2184 by 1690 pixels; 45° FOV:
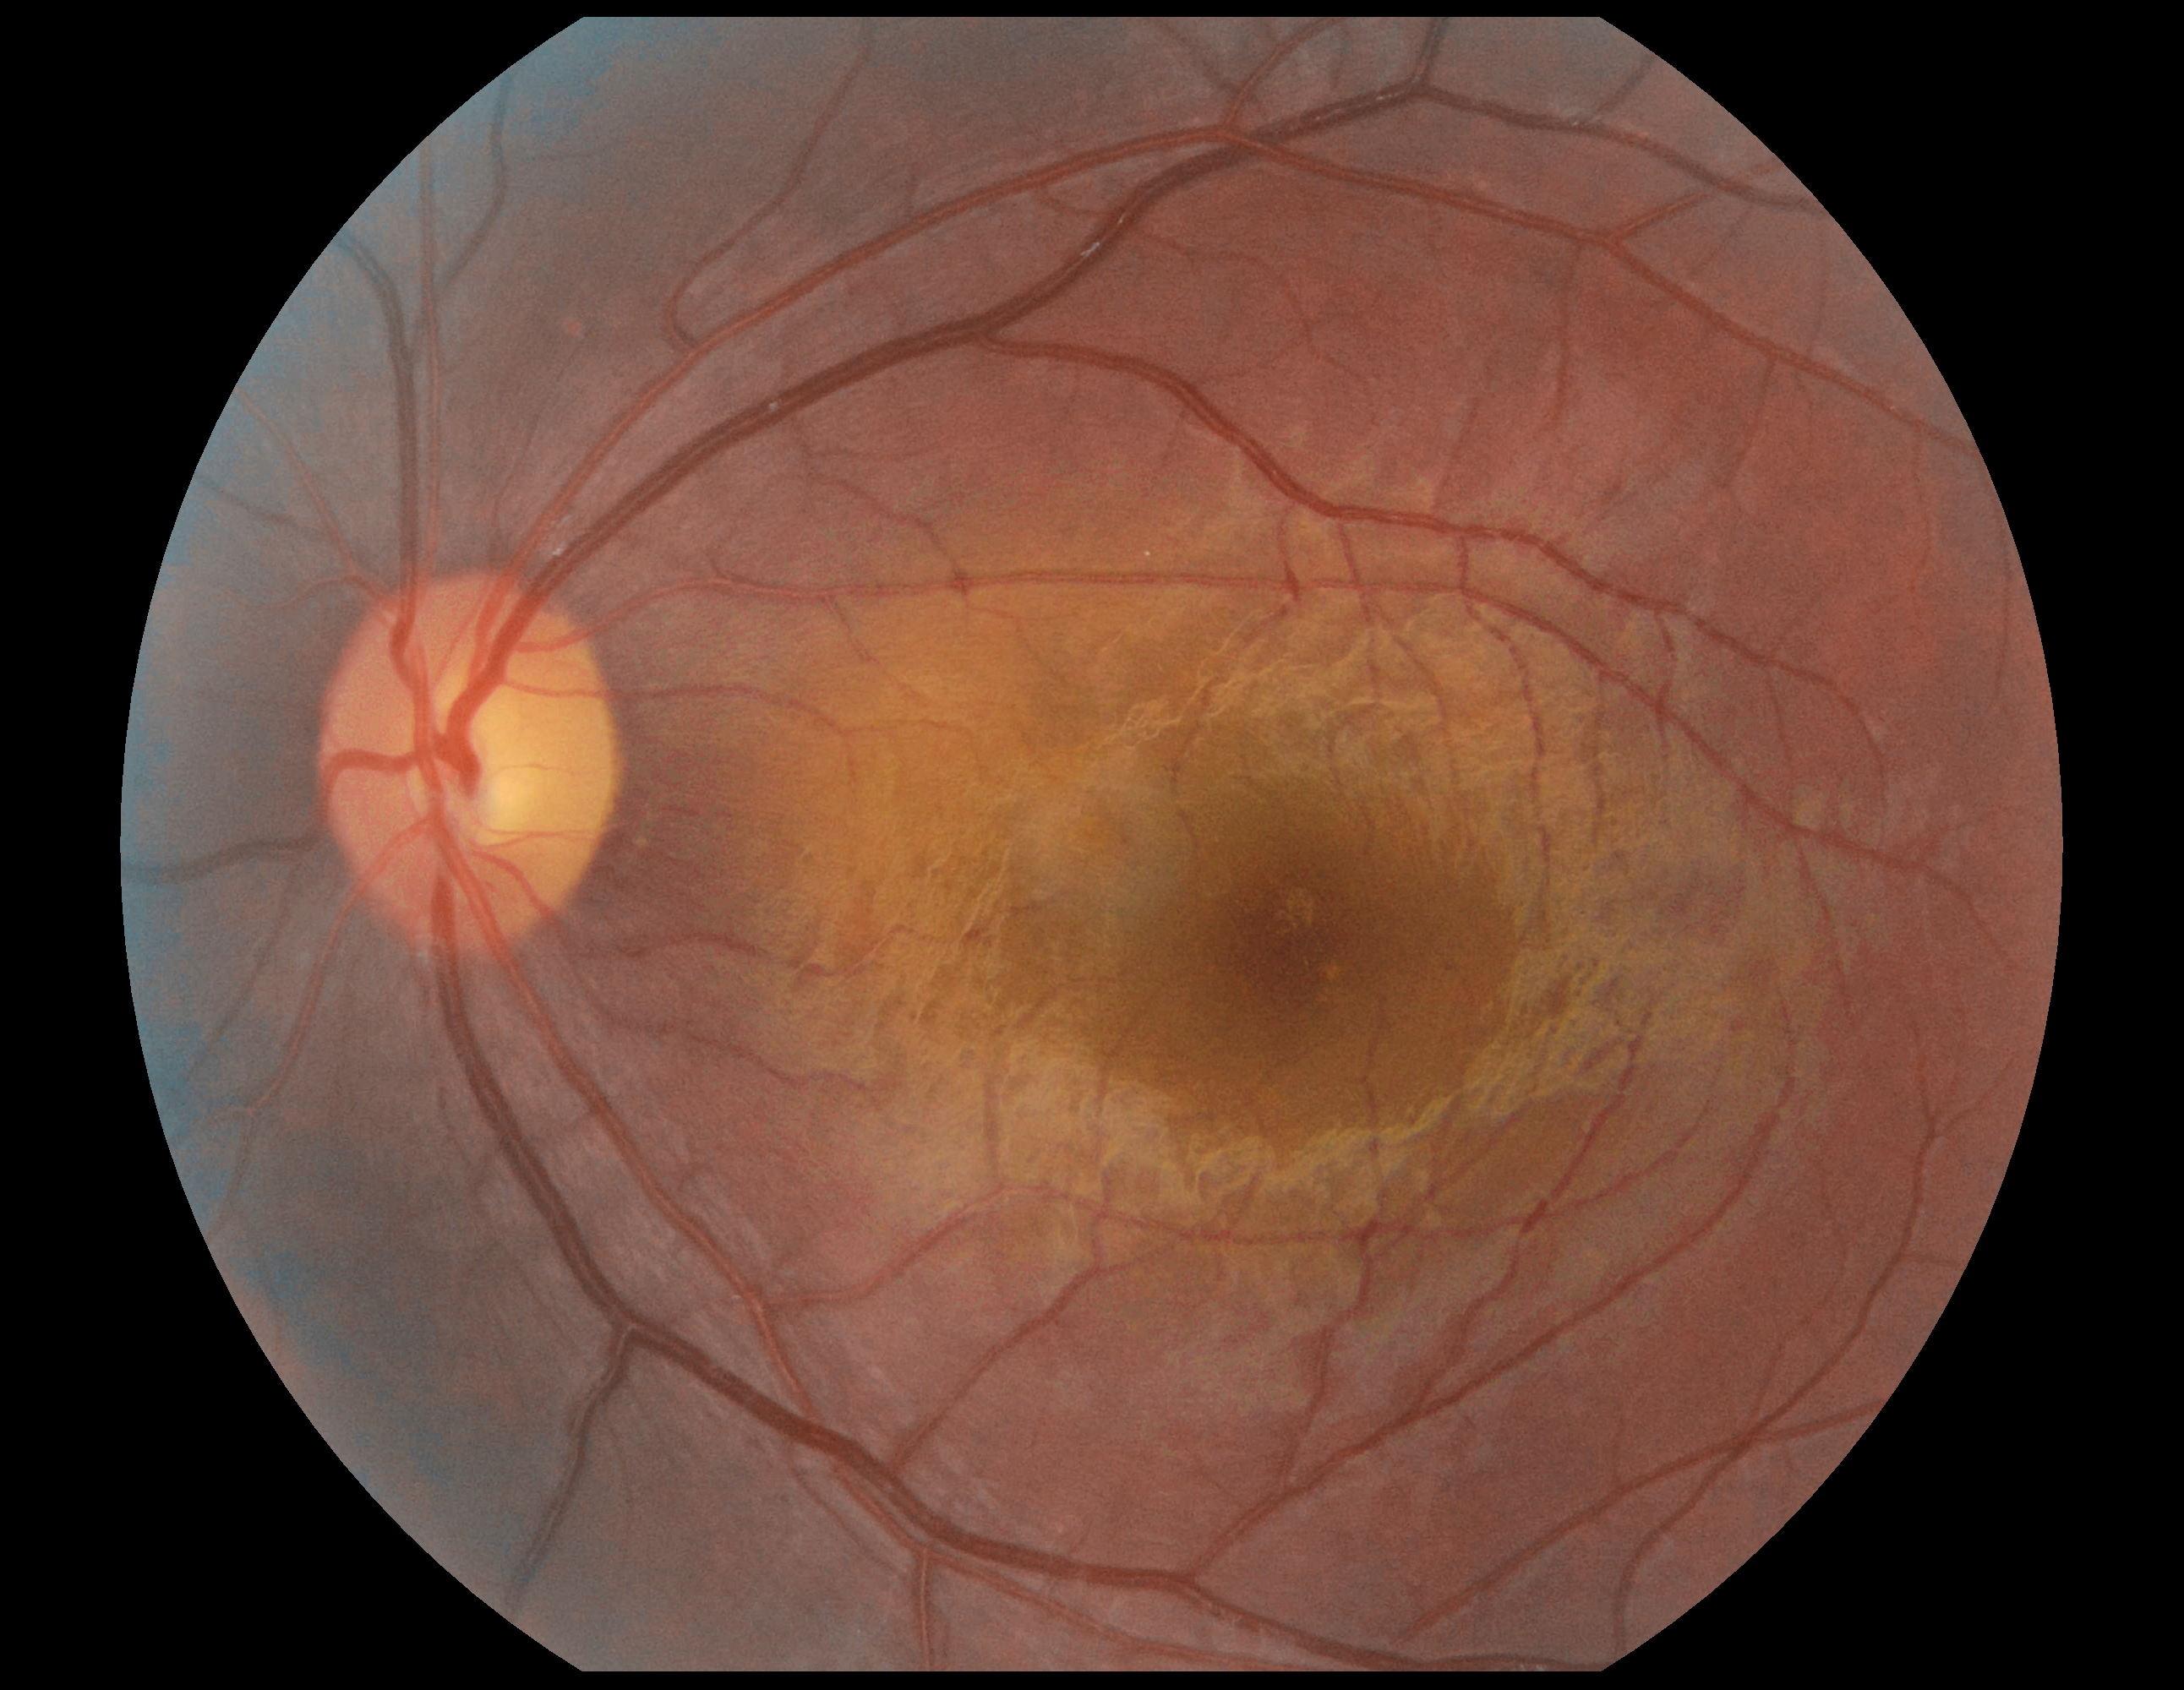
{
  "dr_grade": "0 (no apparent retinopathy)",
  "dr_impression": "no DR findings"
}